848 x 848 pixels; modified Davis grading; NIDEK AFC-230.
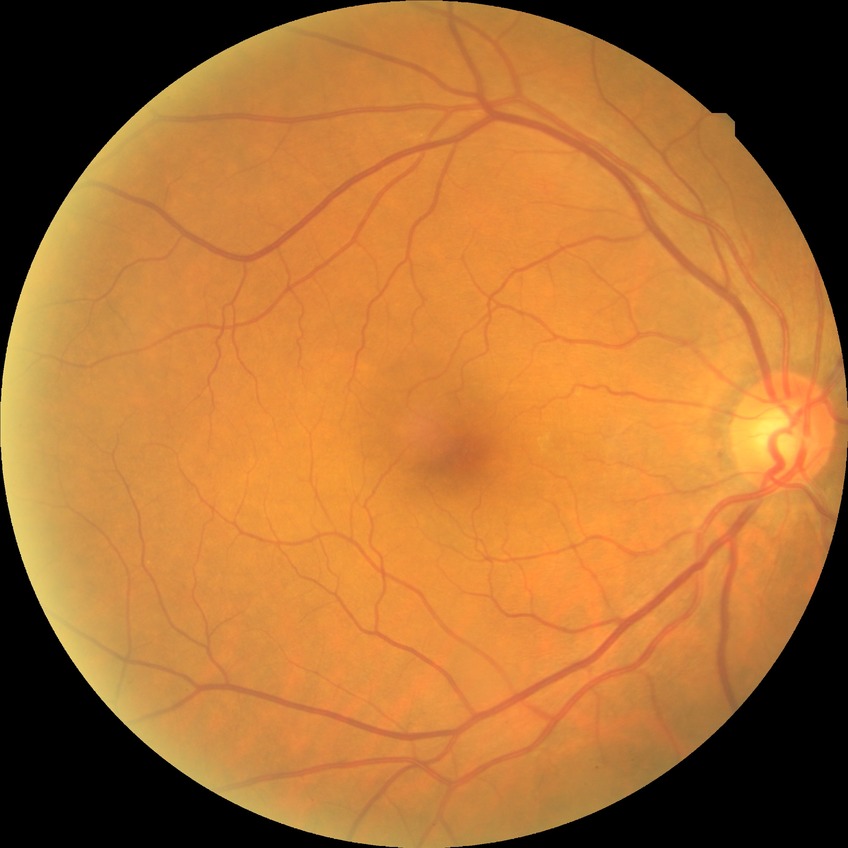
Diabetic retinopathy (DR): NDR (no diabetic retinopathy).